45° FOV
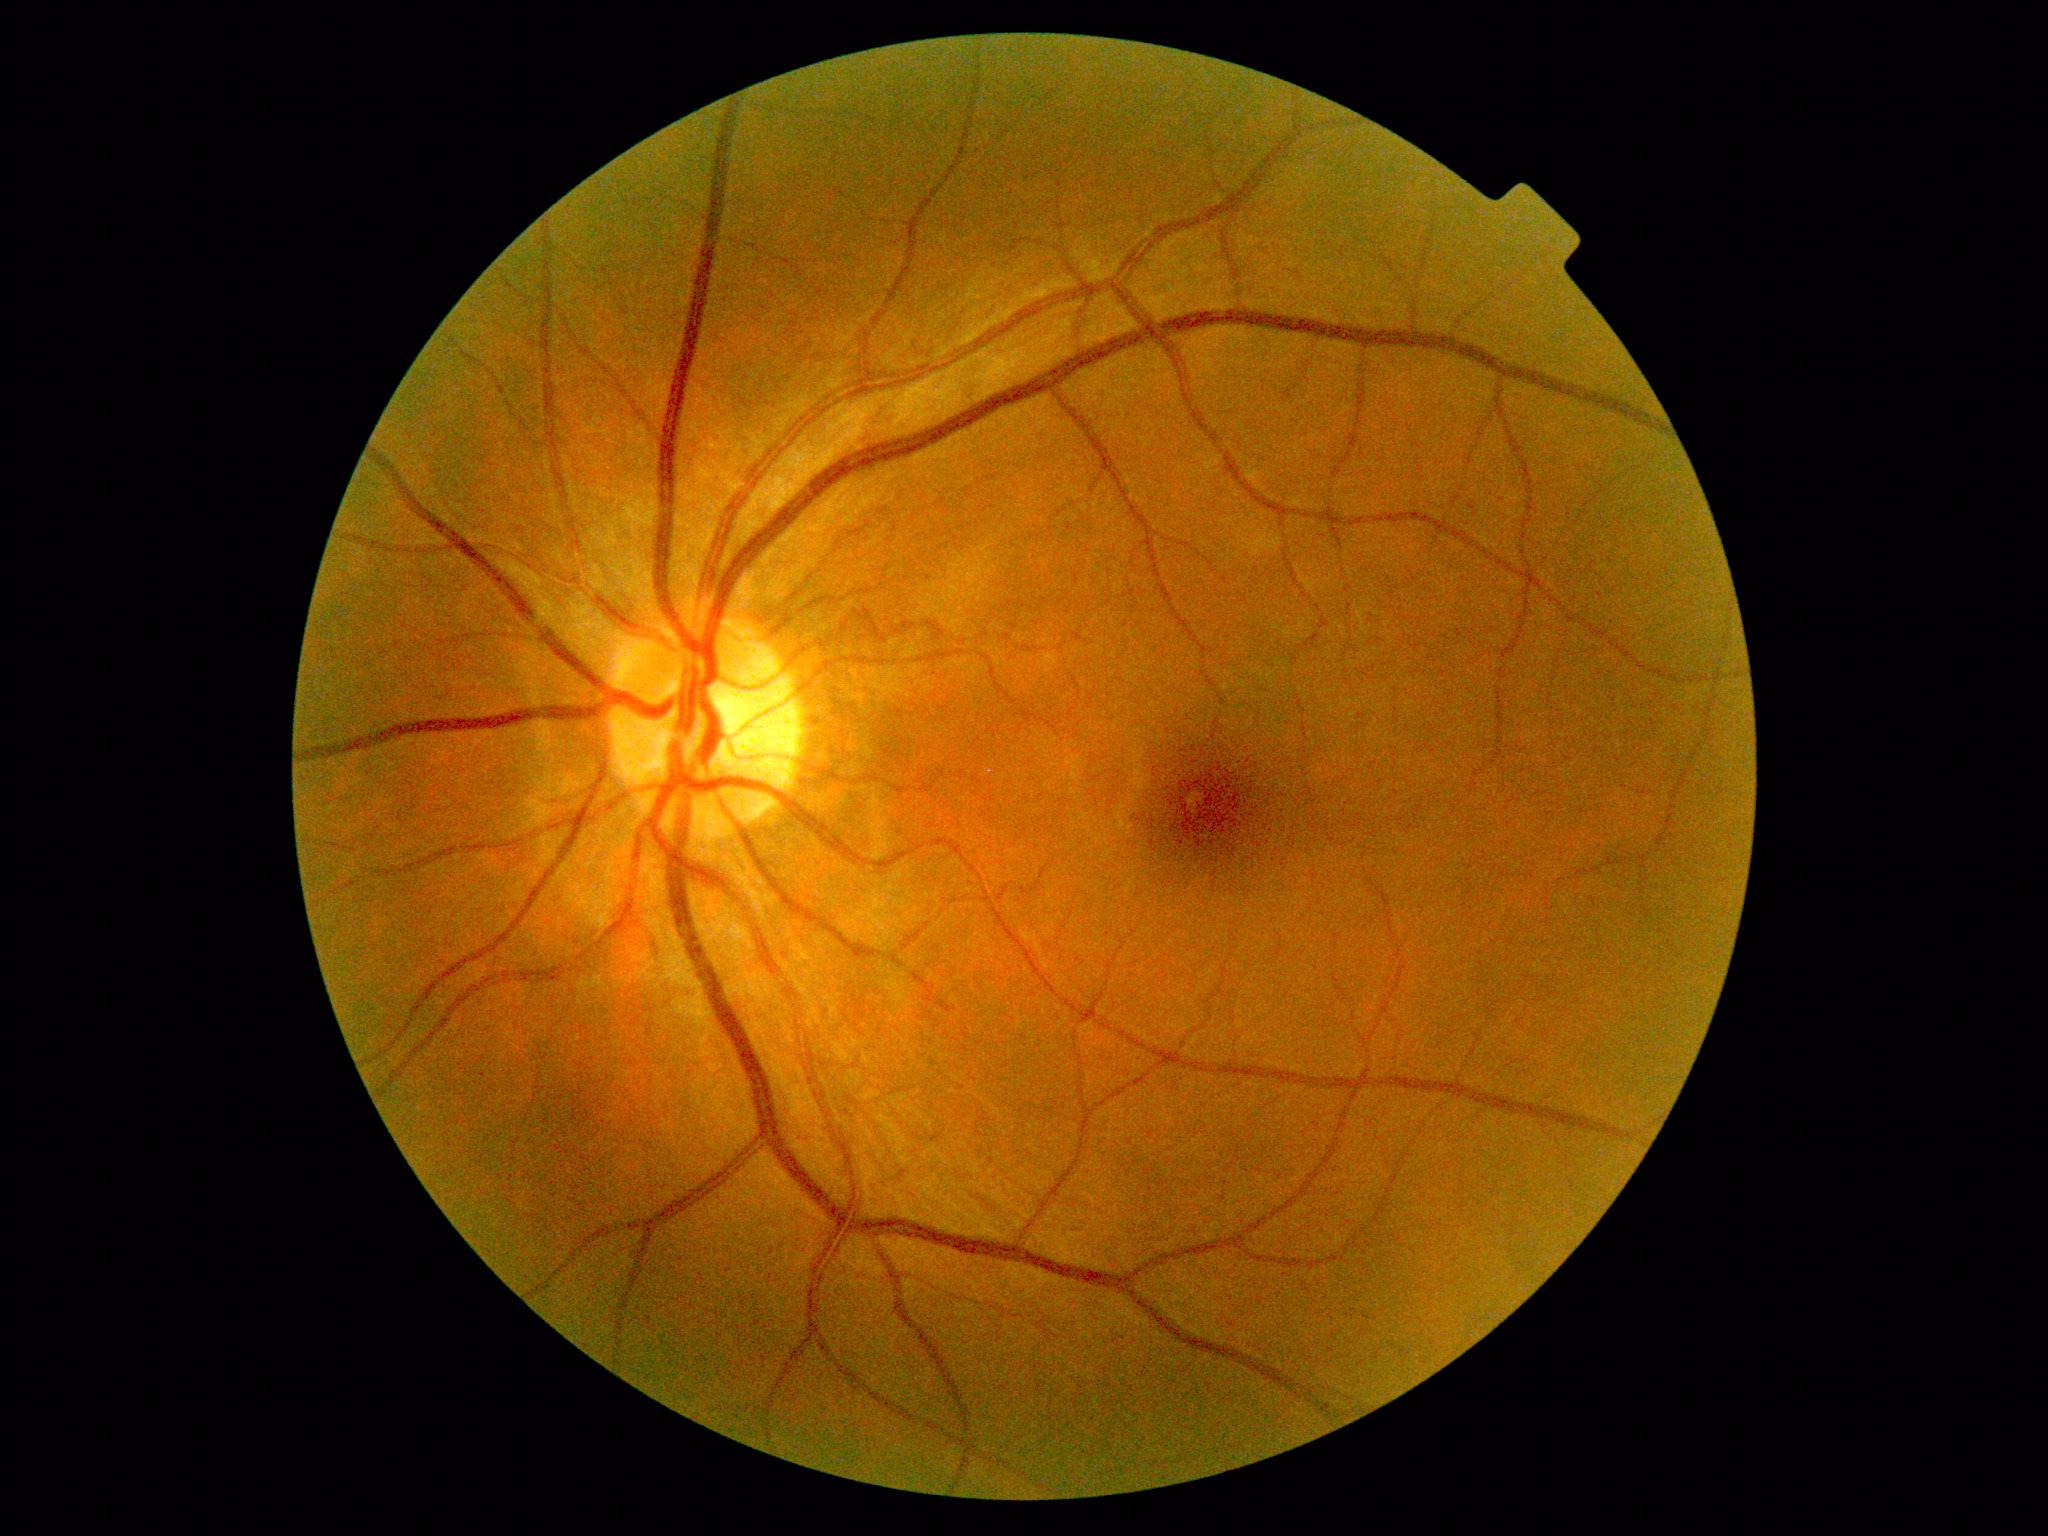

Diabetic retinopathy grade: no apparent diabetic retinopathy (0) — no visible signs of diabetic retinopathy.